Topcon TRC-NW400. Non-mydriatic acquisition: 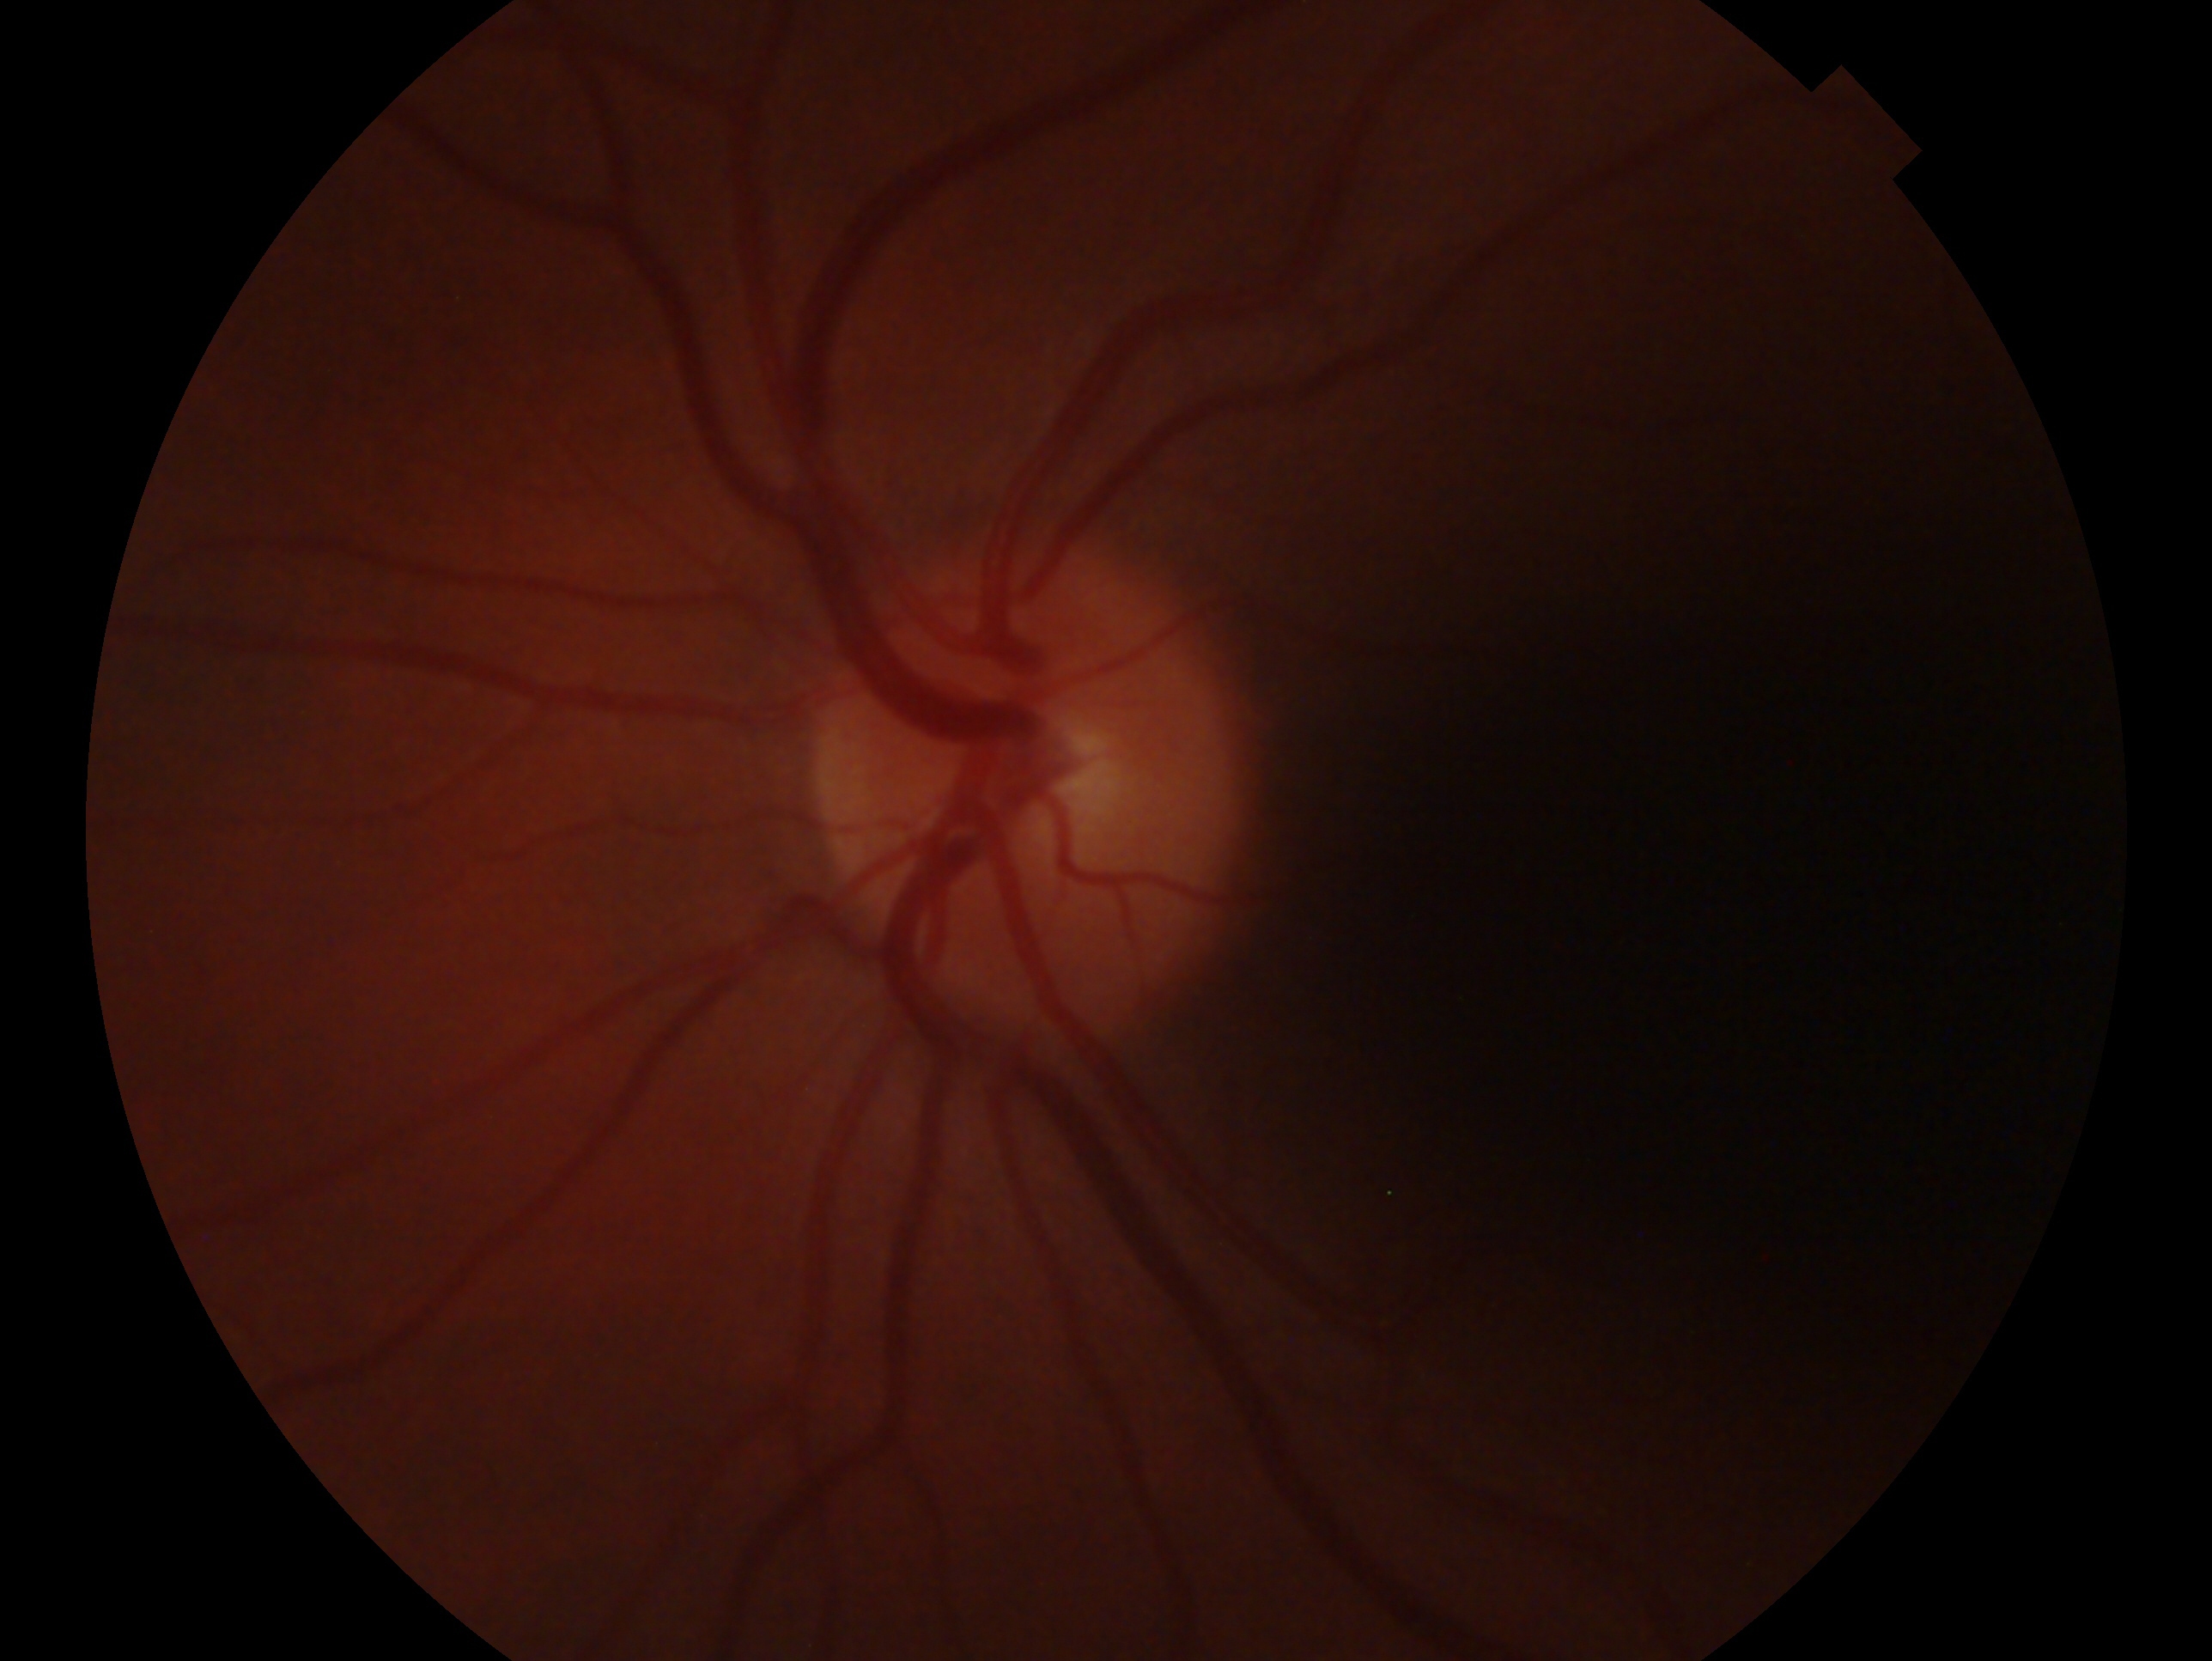
Assessment — no glaucoma. This is the left eye.